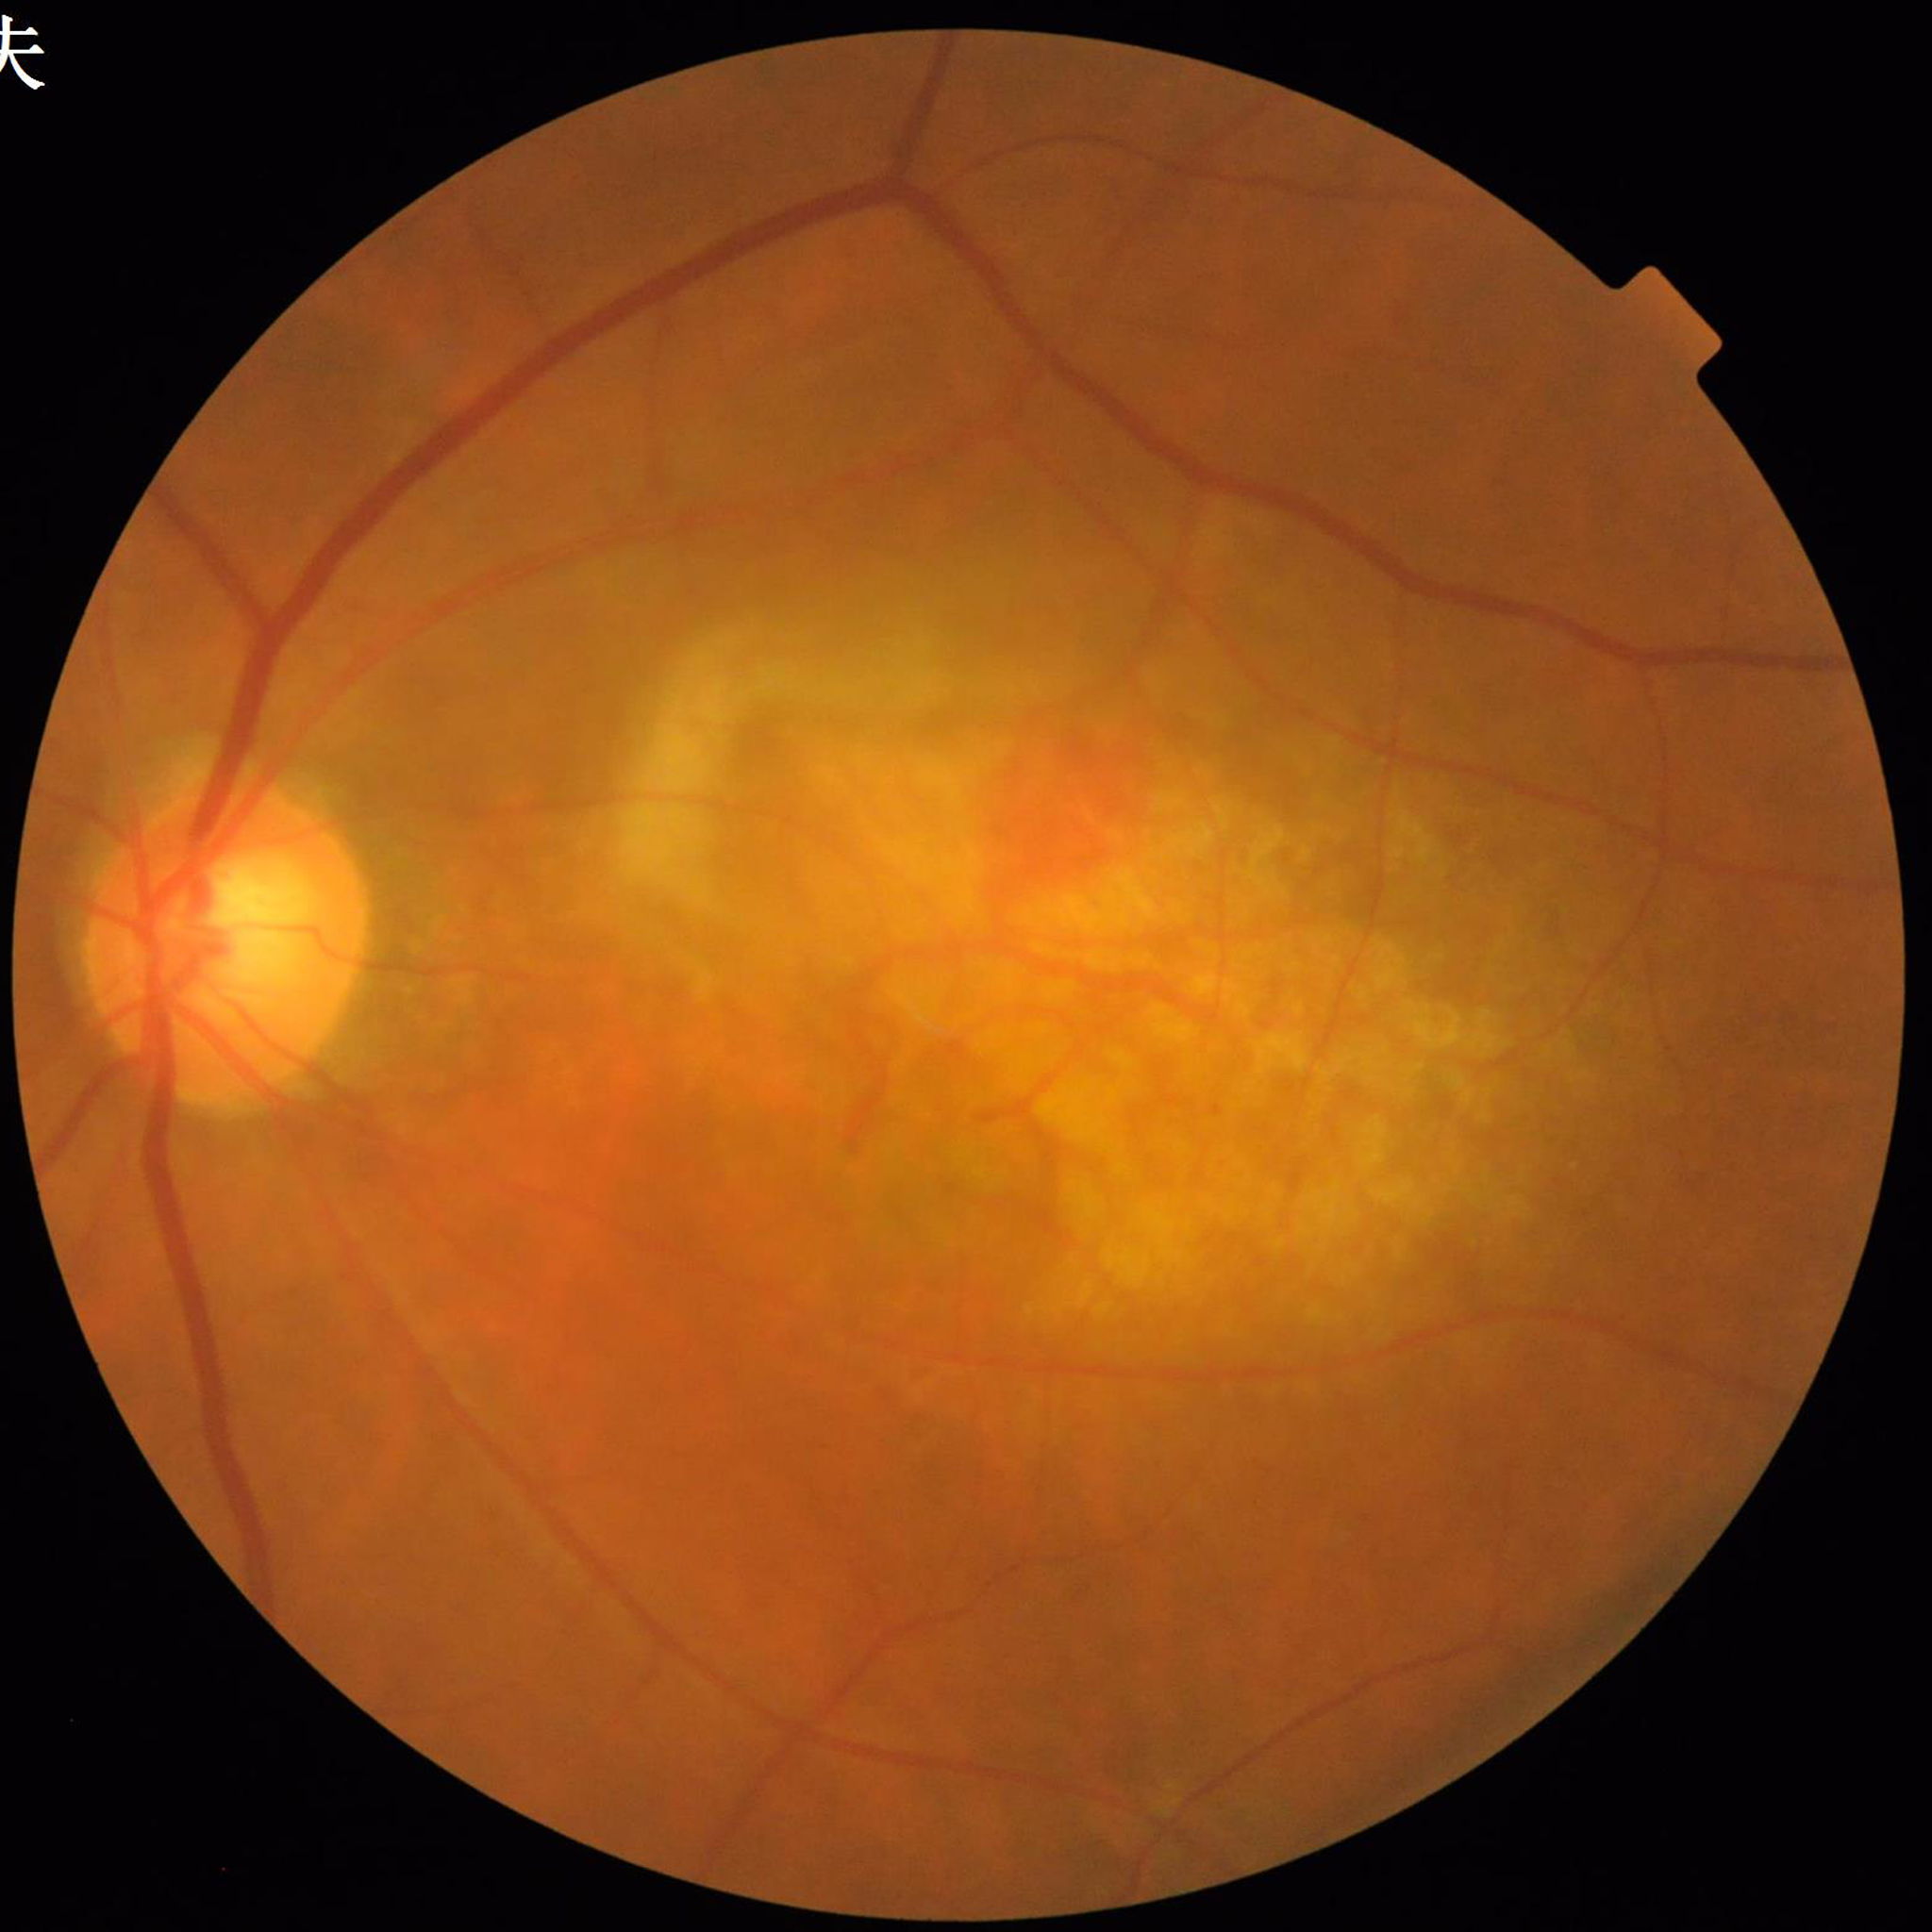 Disease = age-related macular degeneration (AMD).